FOV: 45 degrees: 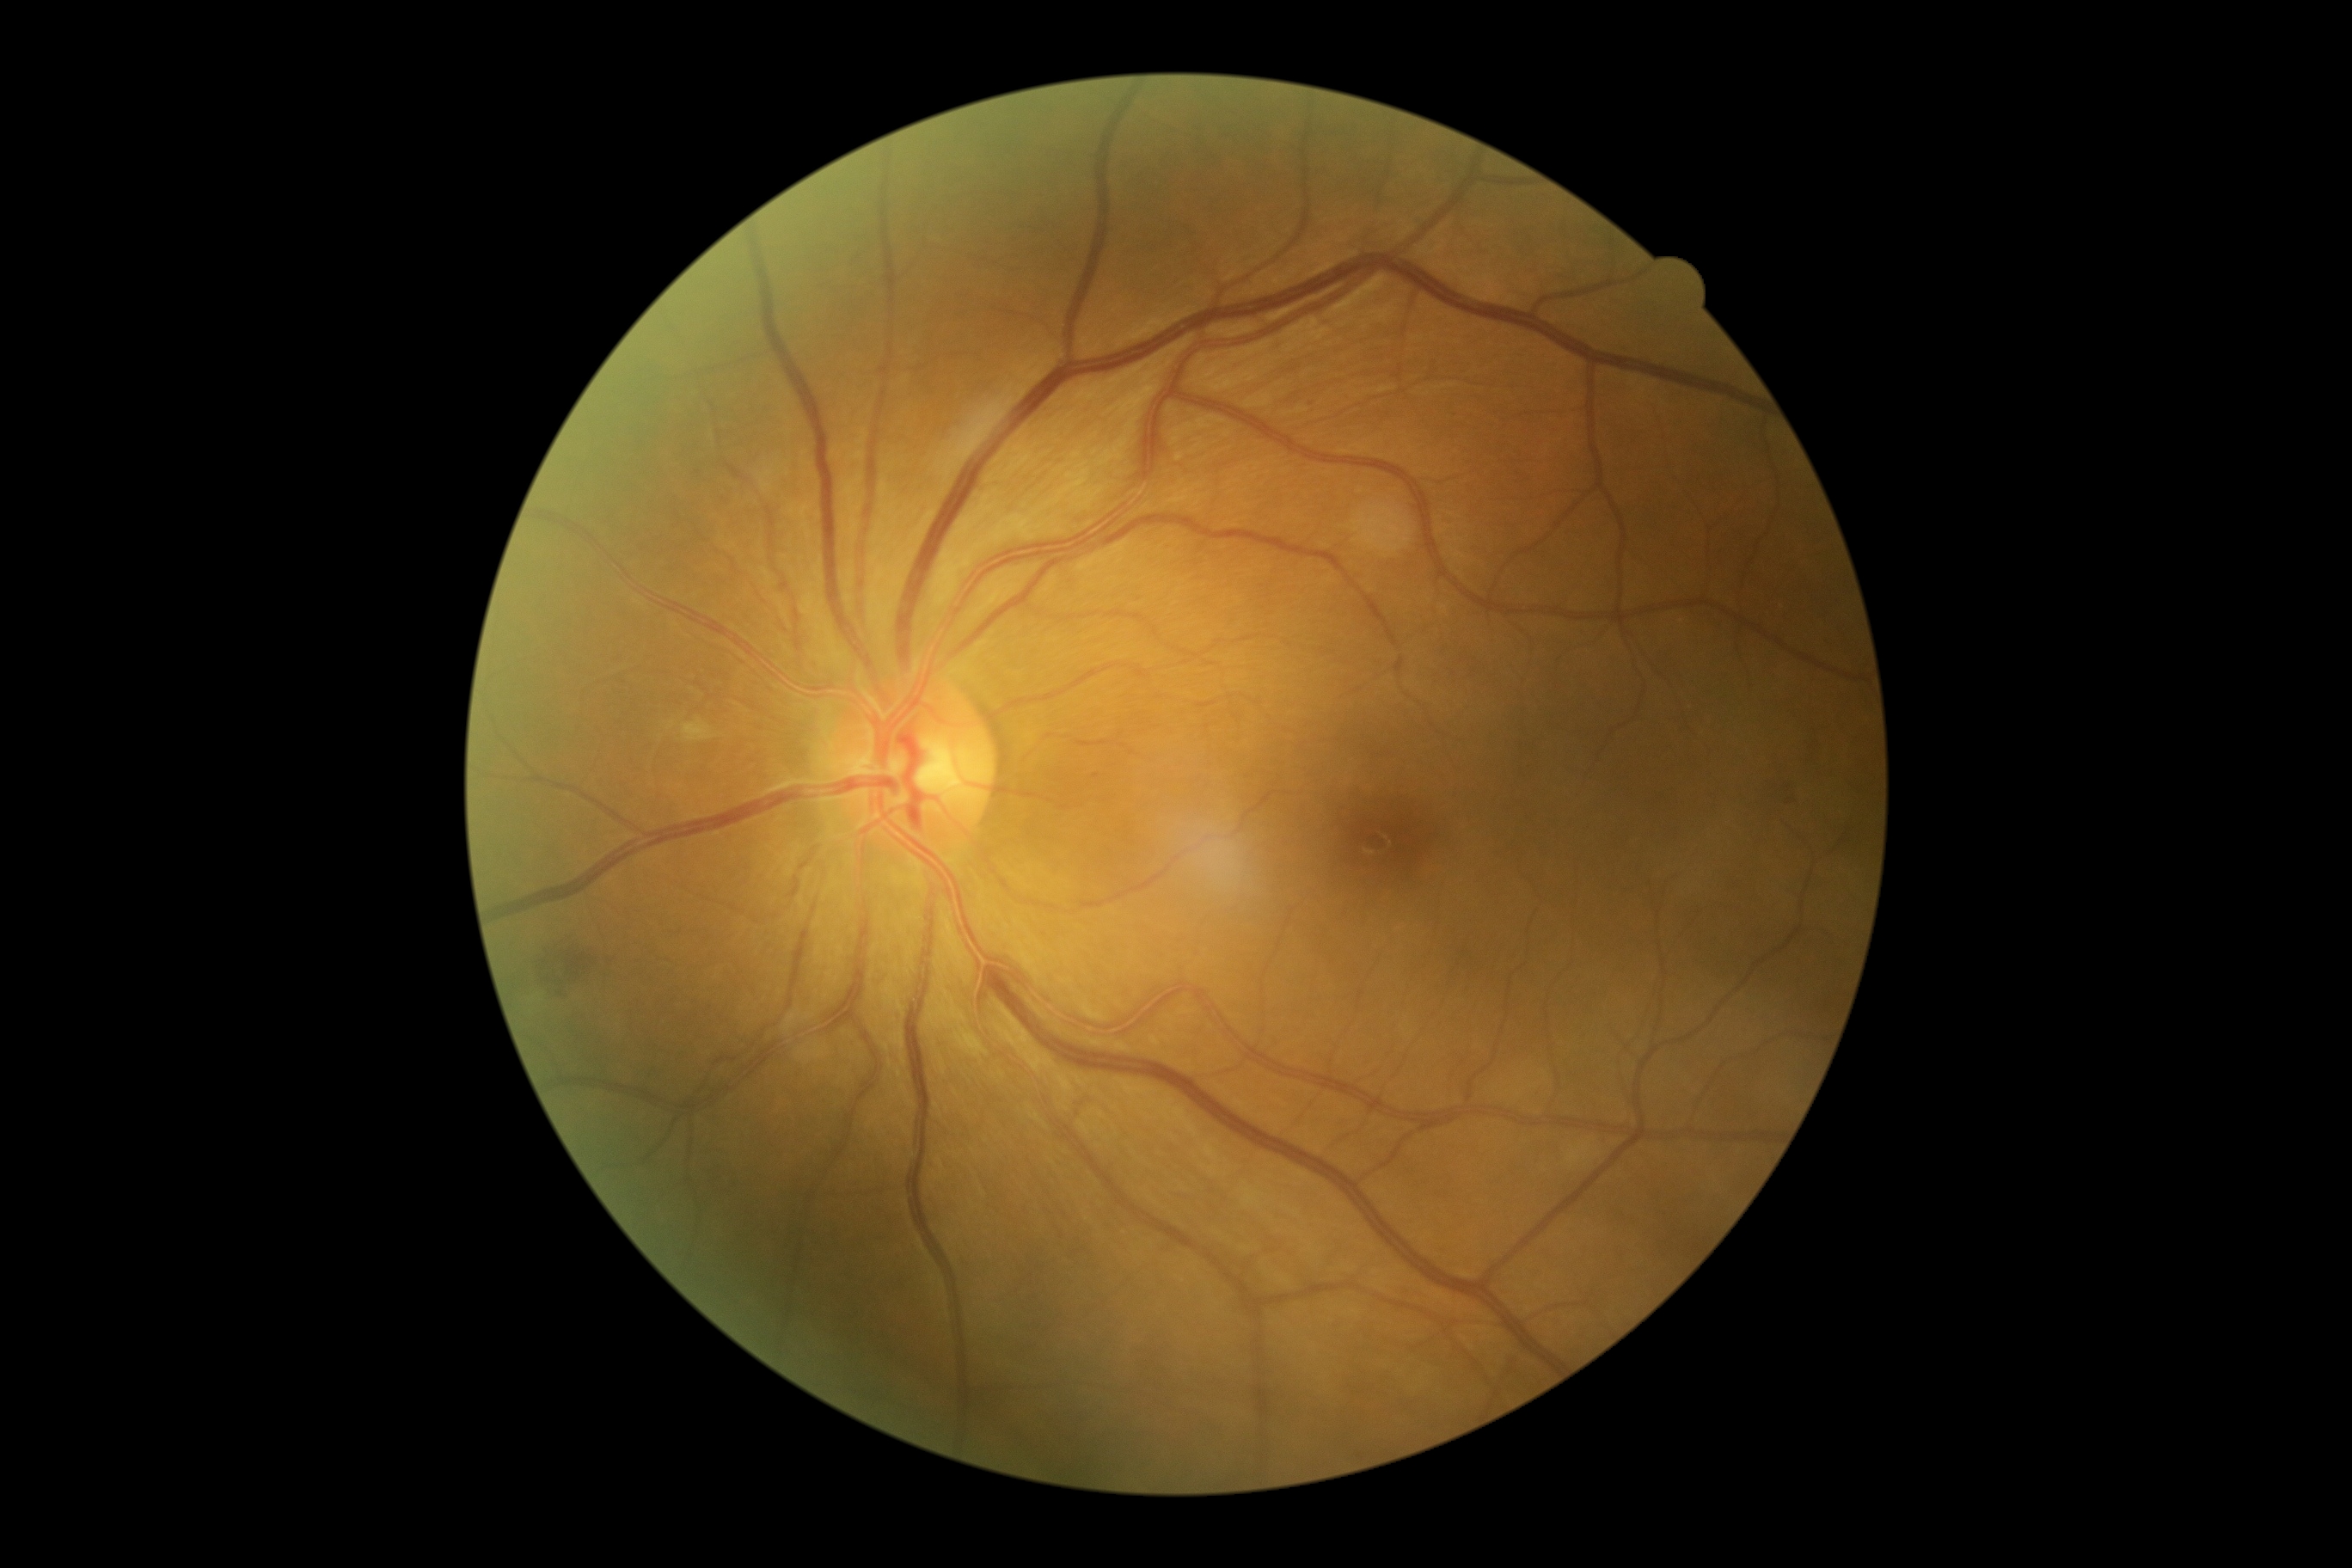 Diabetic retinopathy (DR): 2/4. Disease class: non-proliferative diabetic retinopathy.